512 x 512 pixels, fundus photo: 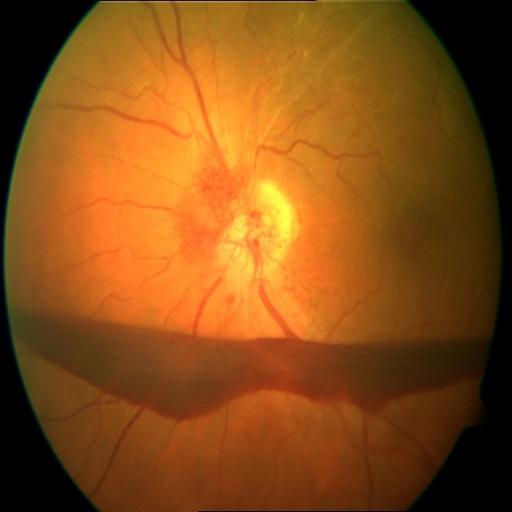

Findings: preretinal hemorrhage (PRH); hemorrhagic retinopathy (HR); optic disc edema (ODE).